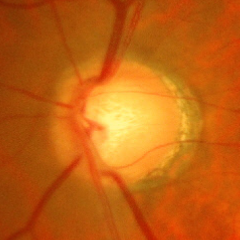
Glaucoma is present. Demonstrates early glaucomatous optic neuropathy.